640x480px; camera: Clarity RetCam 3 (130° FOV); infant wide-field fundus photograph:
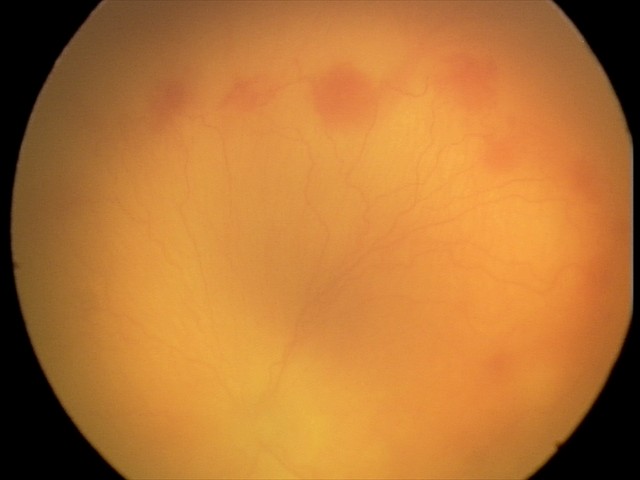

Screening diagnosis: aggressive retinopathy of prematurity (A-ROP); plus disease.